45 degree fundus photograph, nonmydriatic.
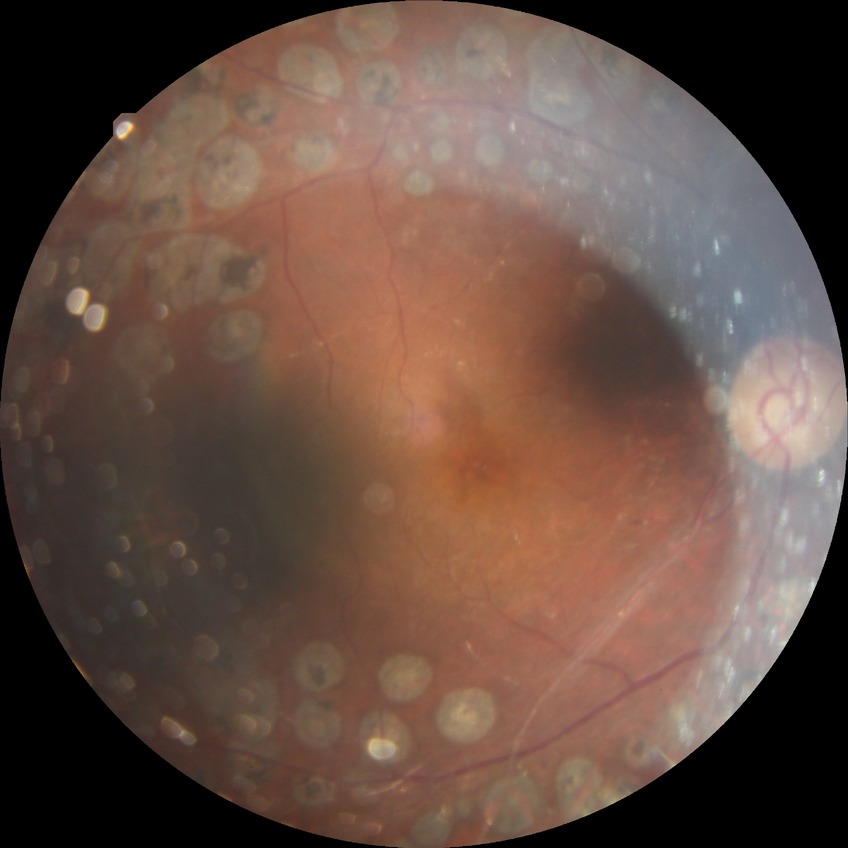 diabetic retinopathy (DR) = proliferative diabetic retinopathy (PDR).